Infant wide-field retinal image · 1240 x 1240 pixels · captured with the Phoenix ICON (100° field of view).
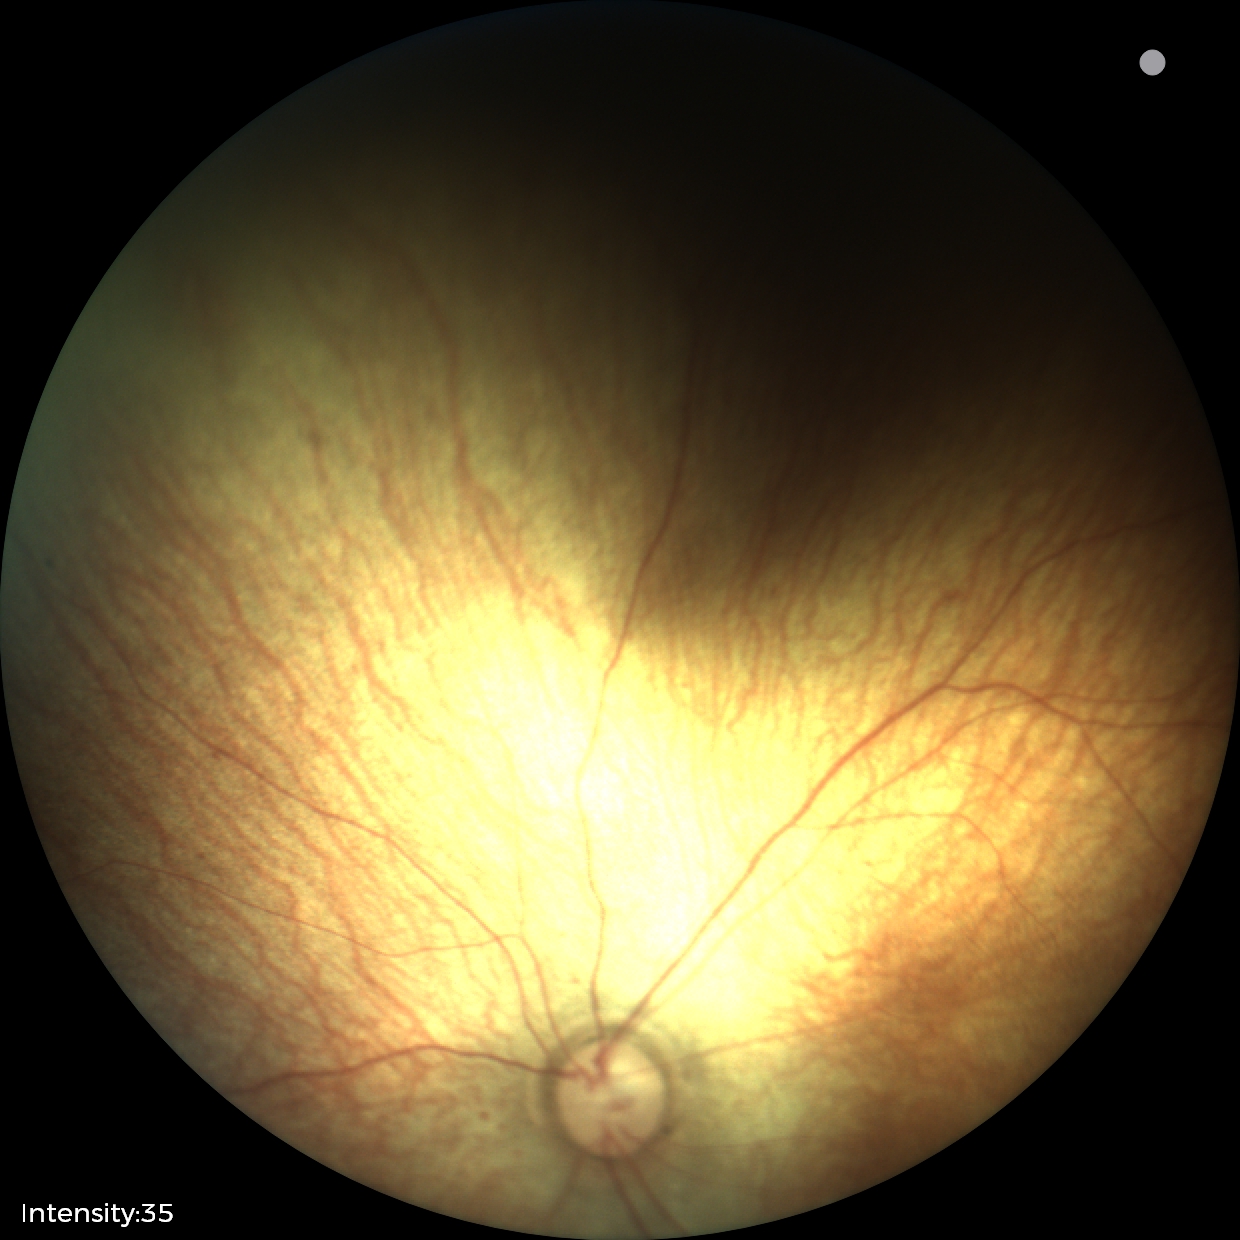 Examination with physiological retinal findings.